2048 by 1536 pixels
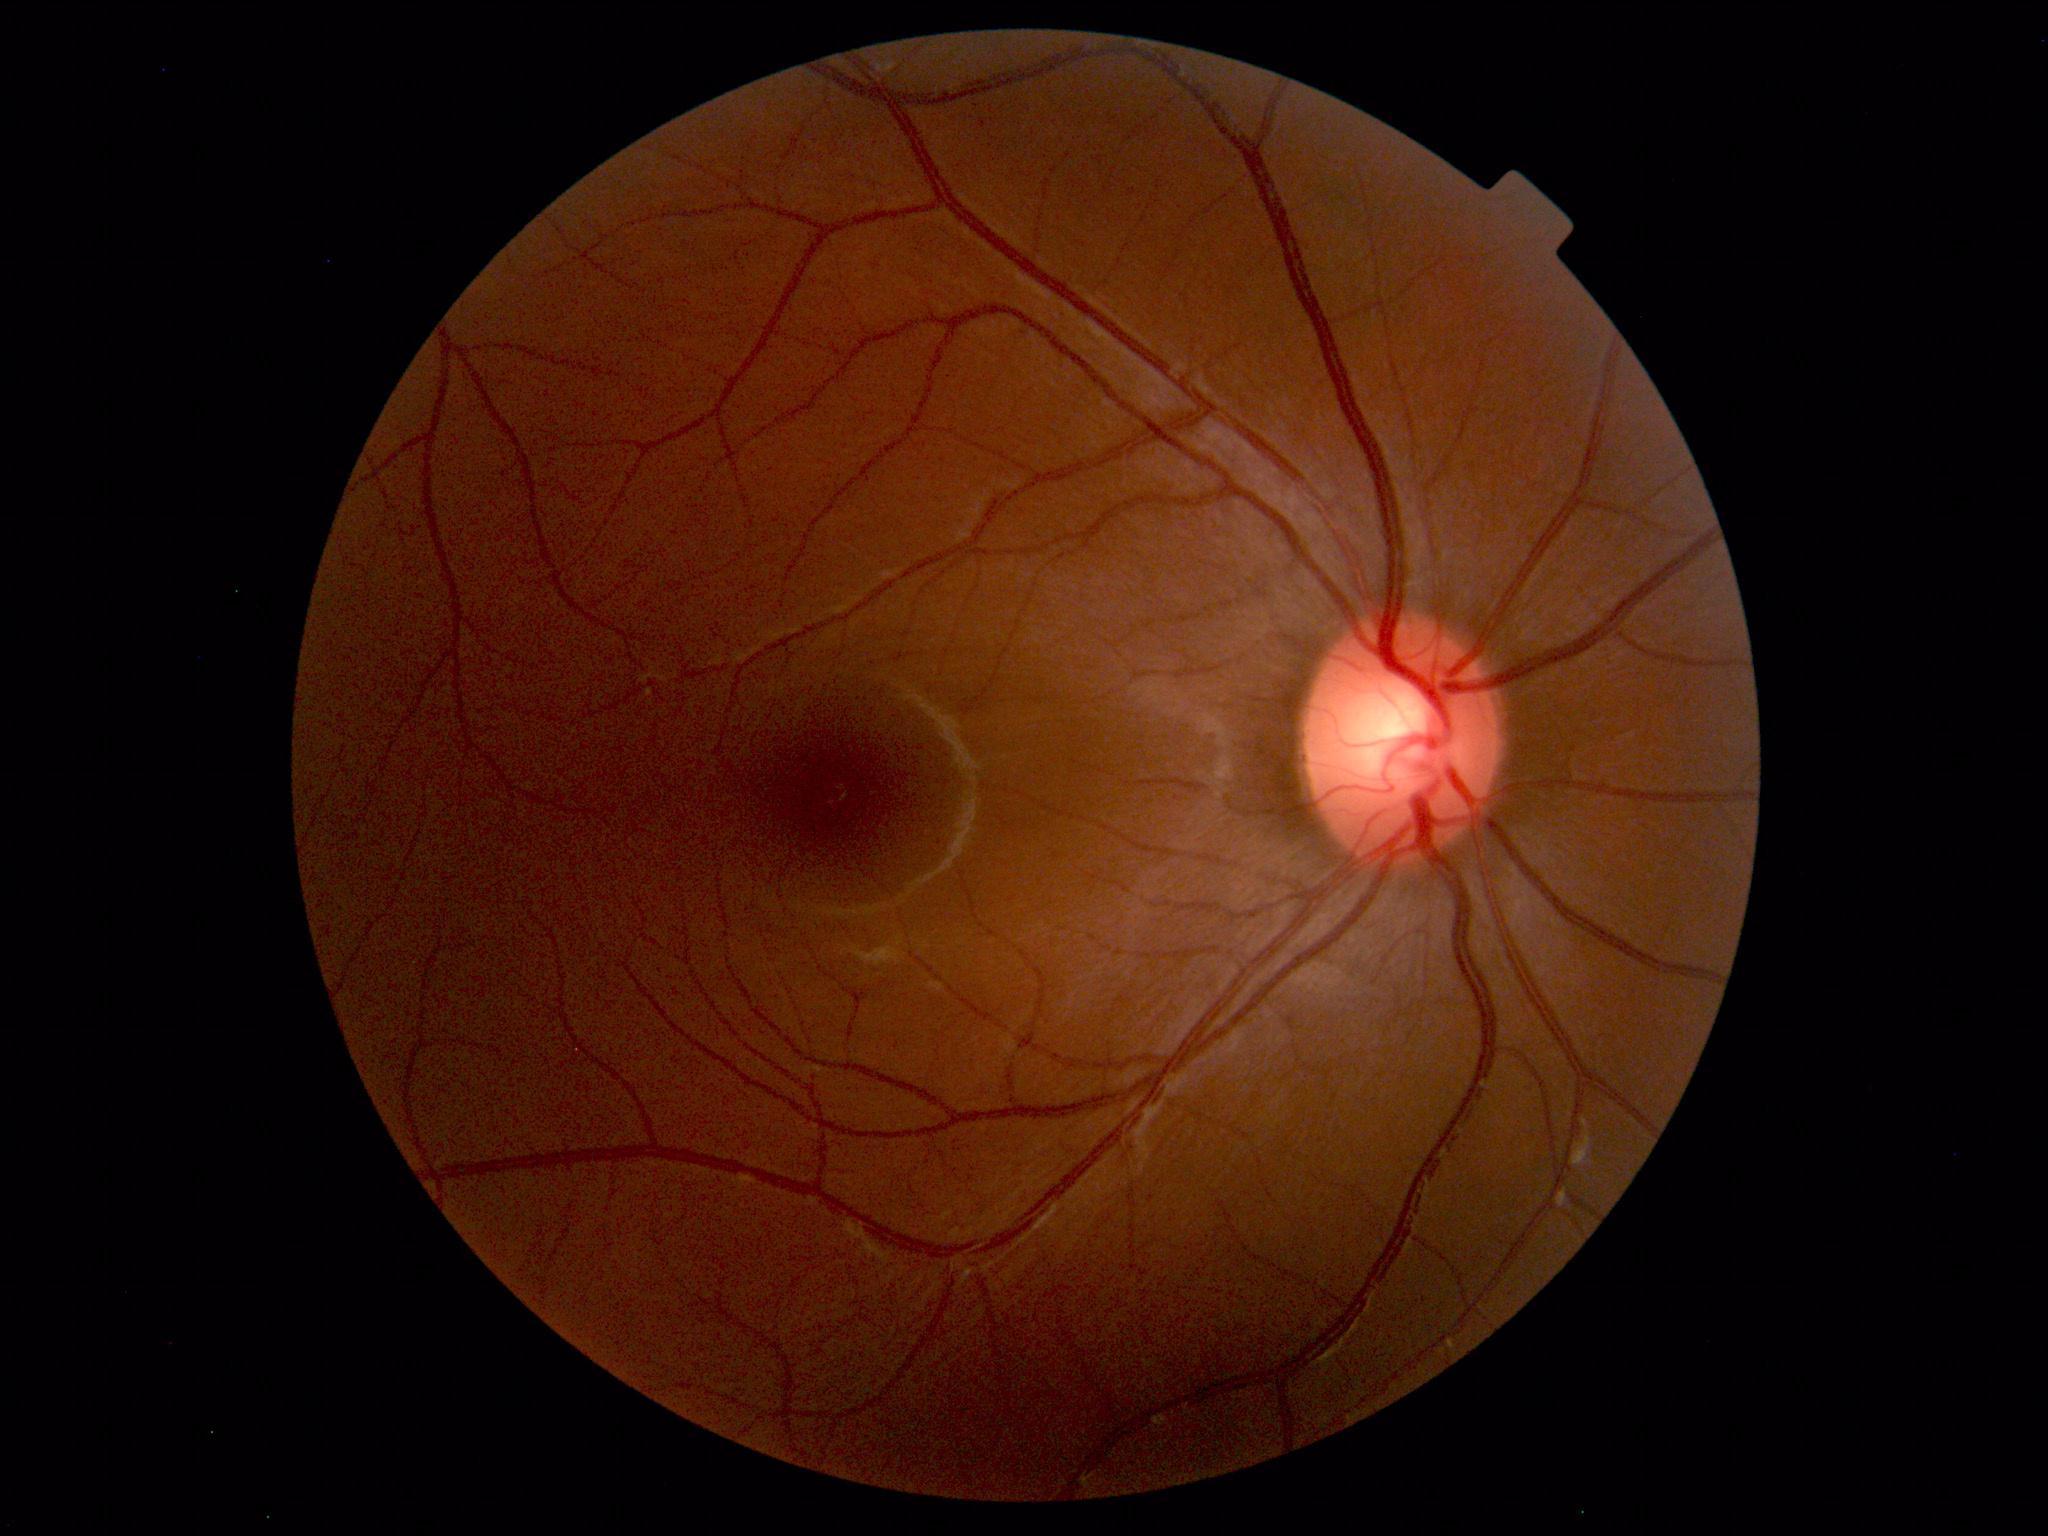

Unremarkable color fundus photograph.